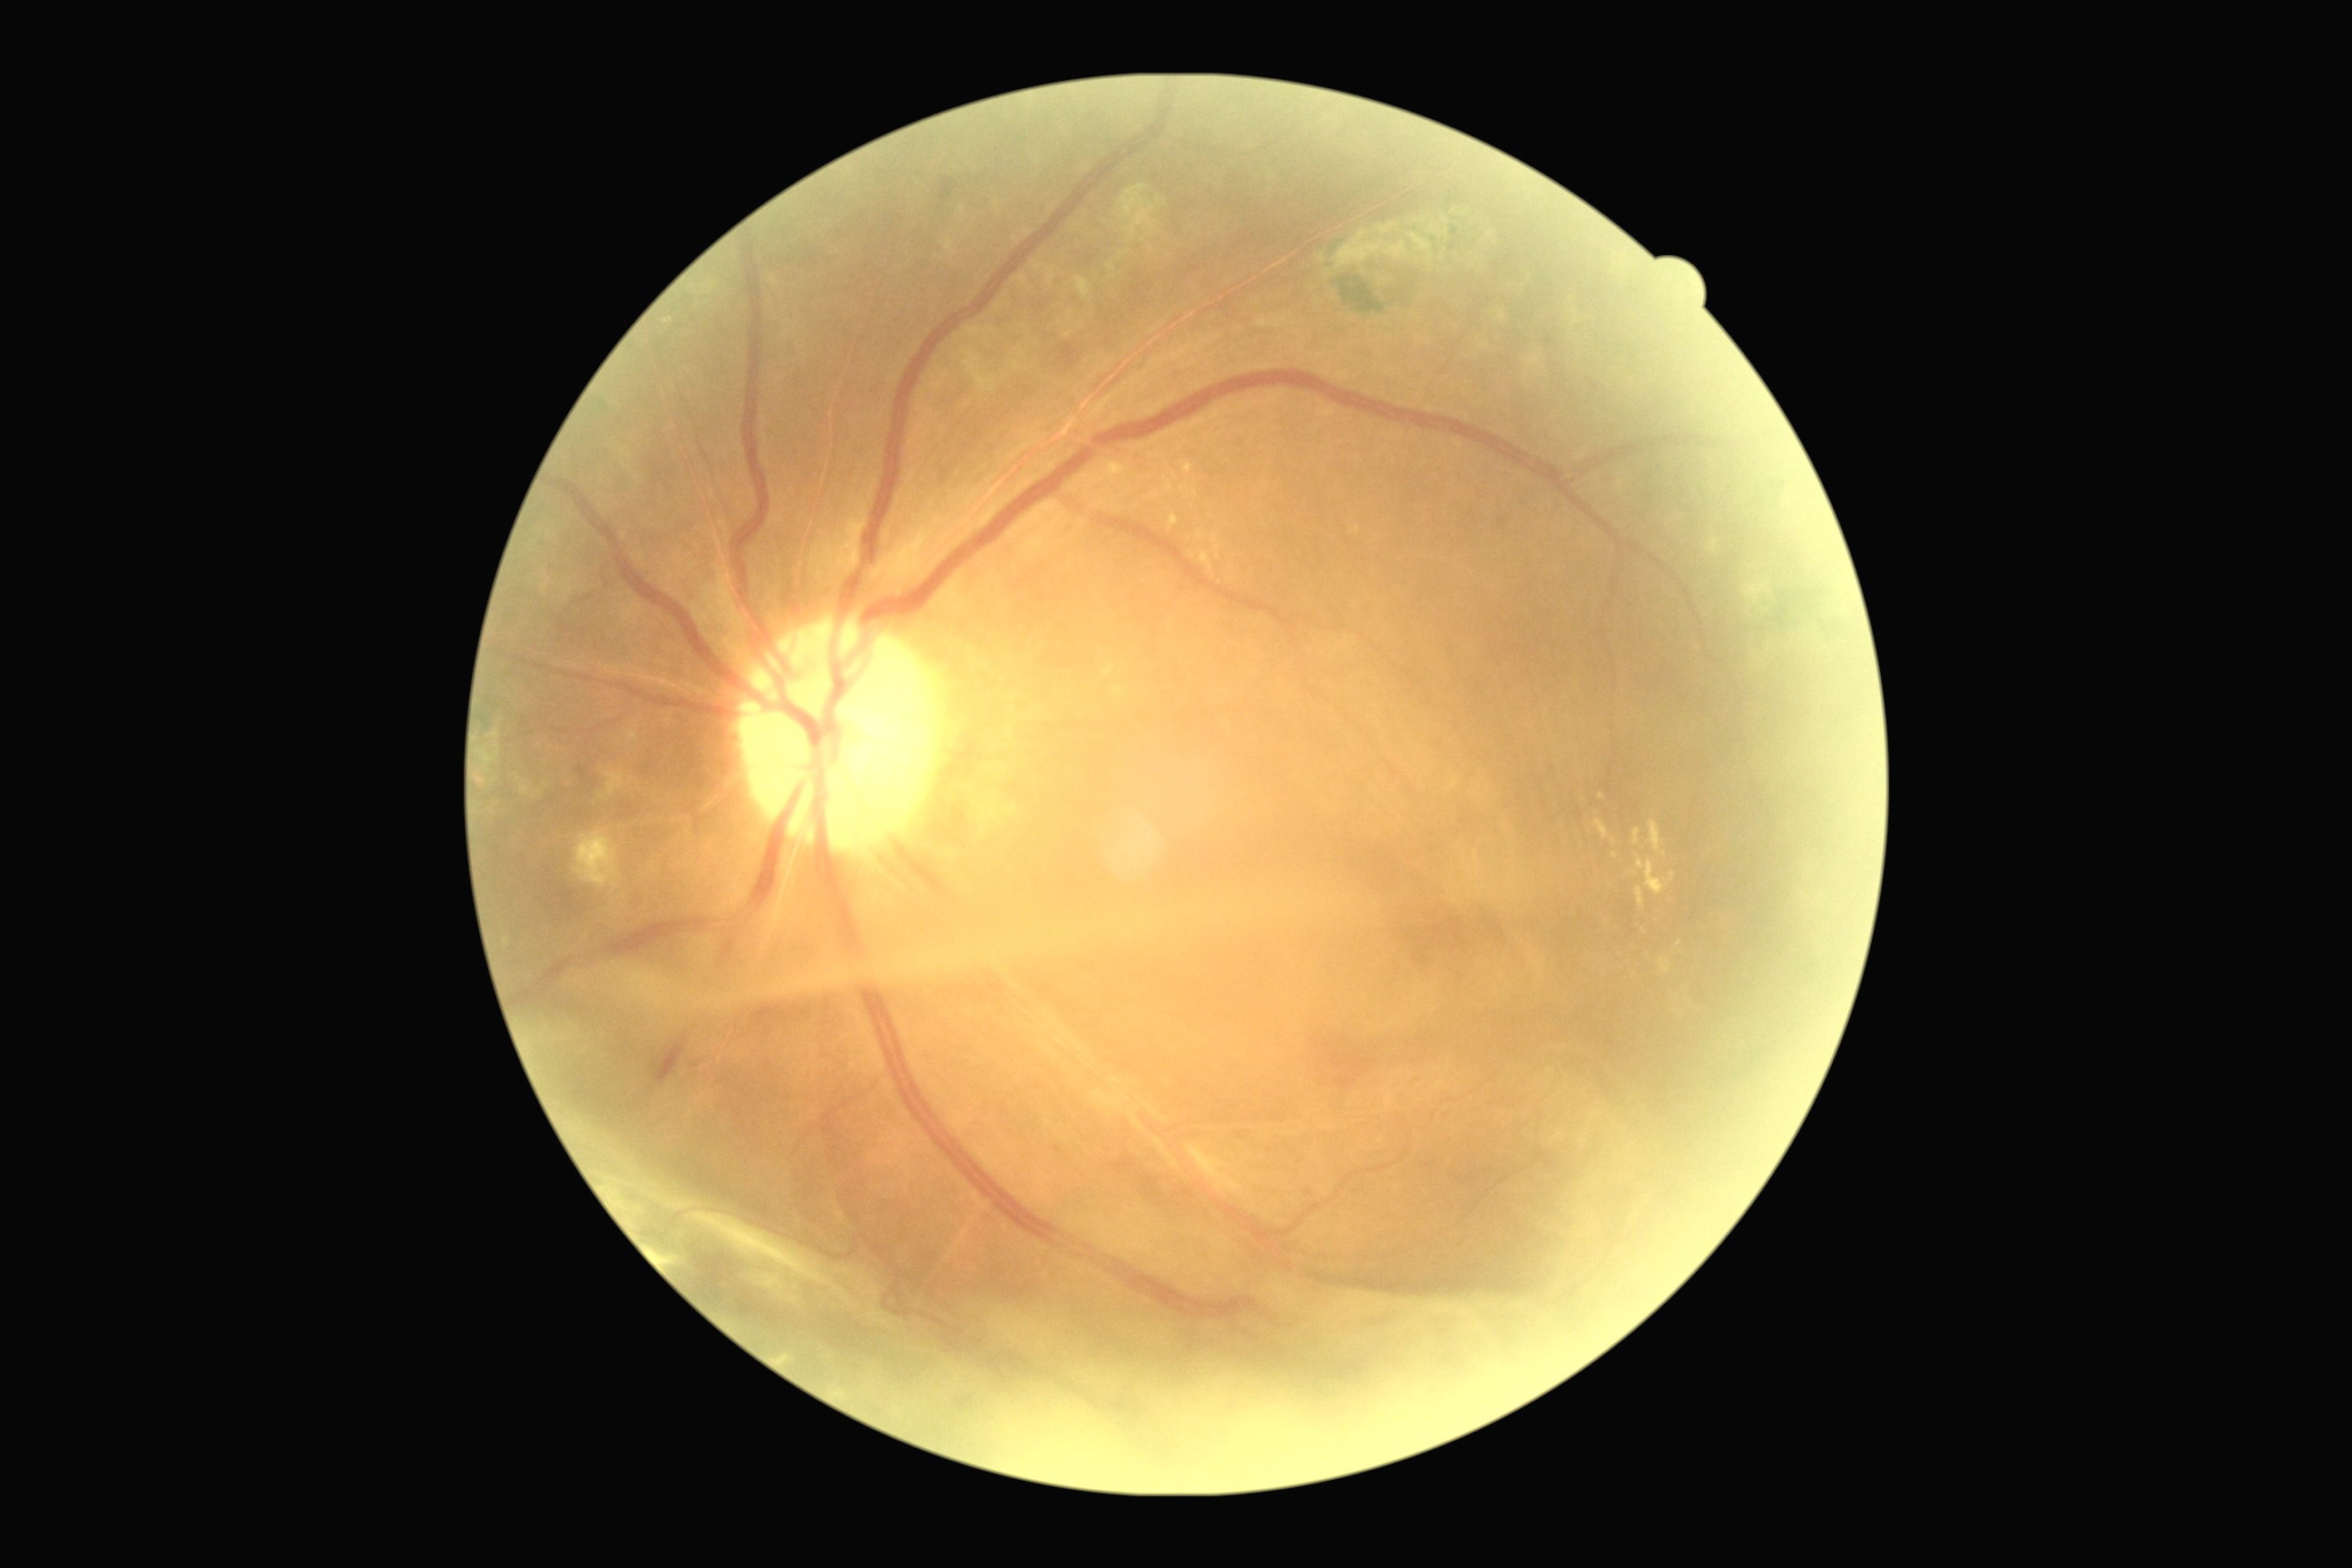
diabetic retinopathy: grade 4 (PDR)